1240 by 1240 pixels; pediatric retinal photograph (wide-field)
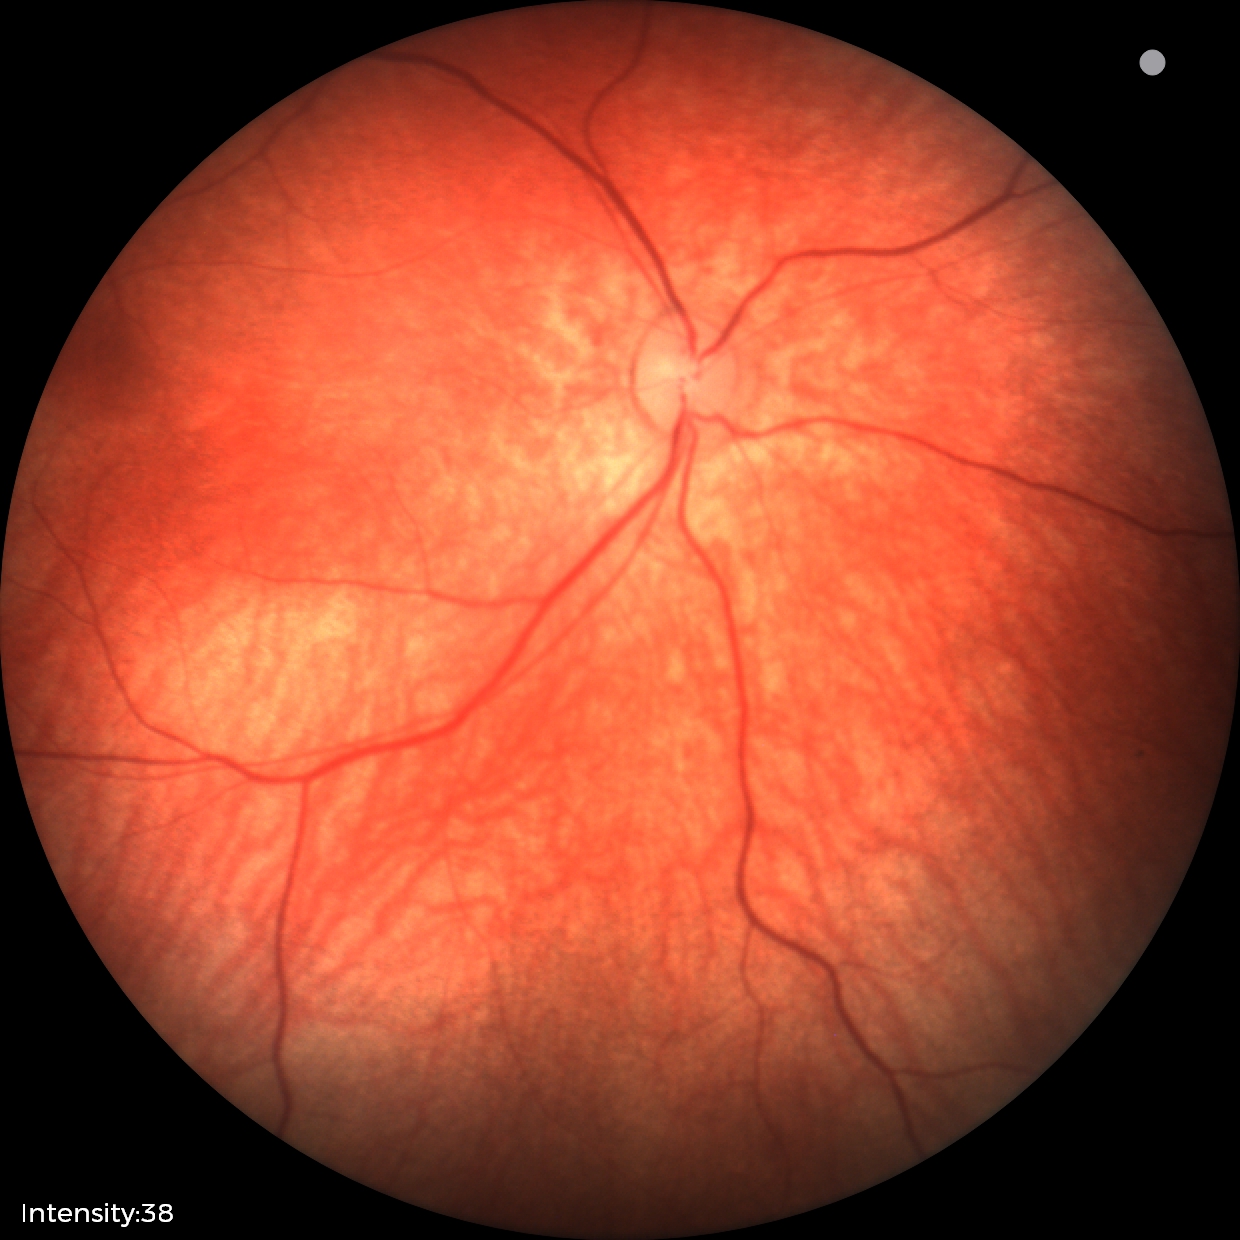 Finding: normal.